Wide-field fundus photograph from neonatal ROP screening · 640x480
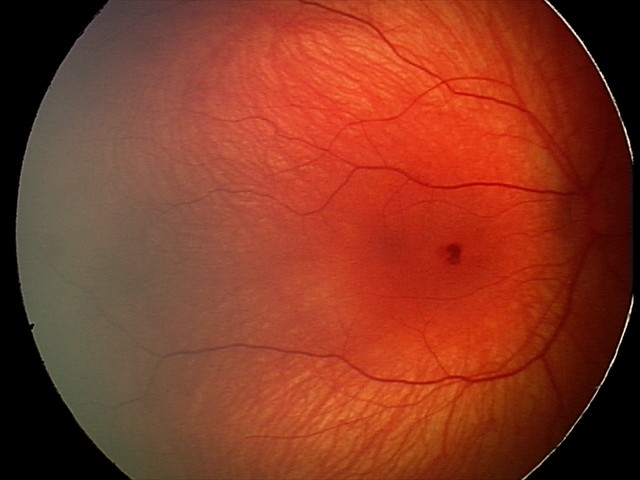 Assessment = retinal hemorrhages.